45 degree fundus photograph, acquired with a NIDEK AFC-230, diabetic retinopathy graded by the modified Davis classification, 848x848px
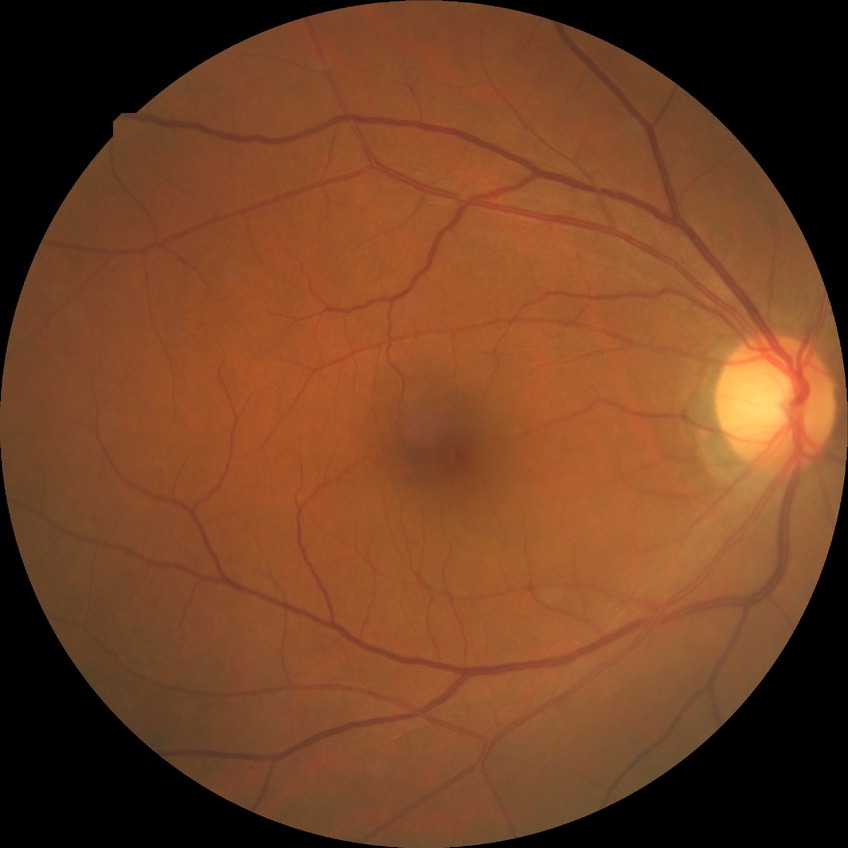
Diabetic retinopathy (DR): NDR (no diabetic retinopathy).